2352x1568 — 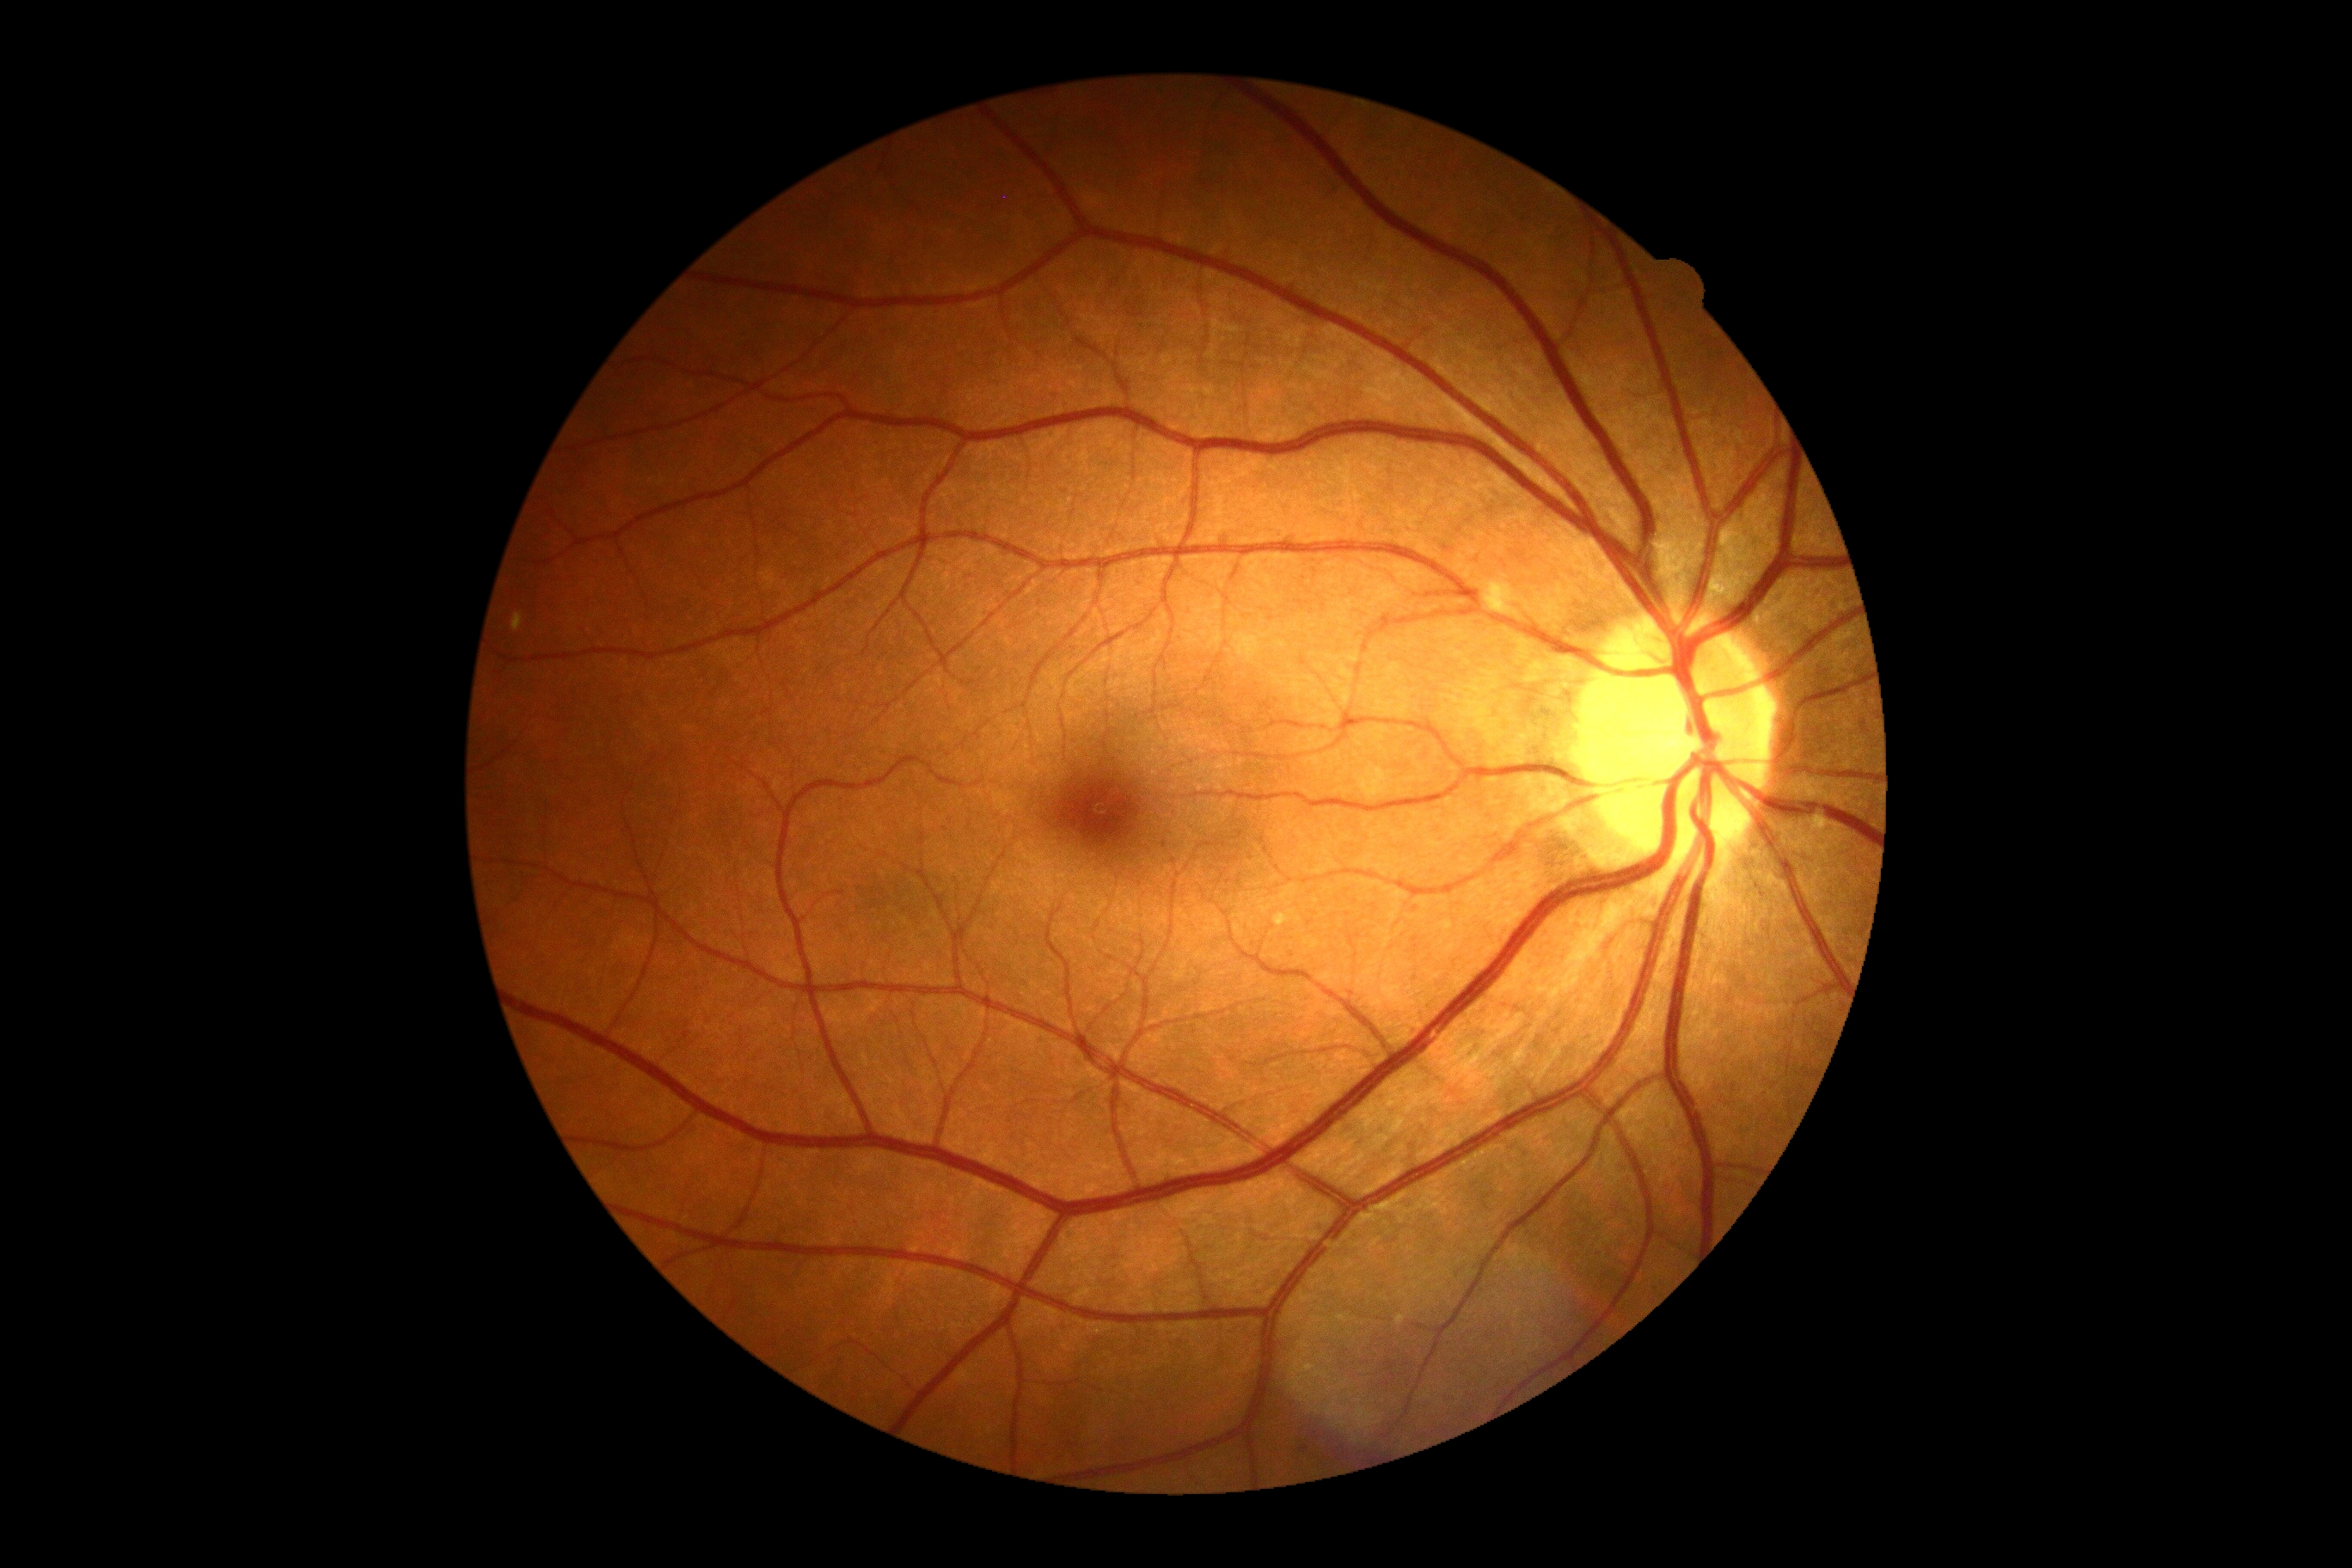
Diabetic retinopathy (DR) is no apparent retinopathy (grade 0).